Infant wide-field fundus photograph: 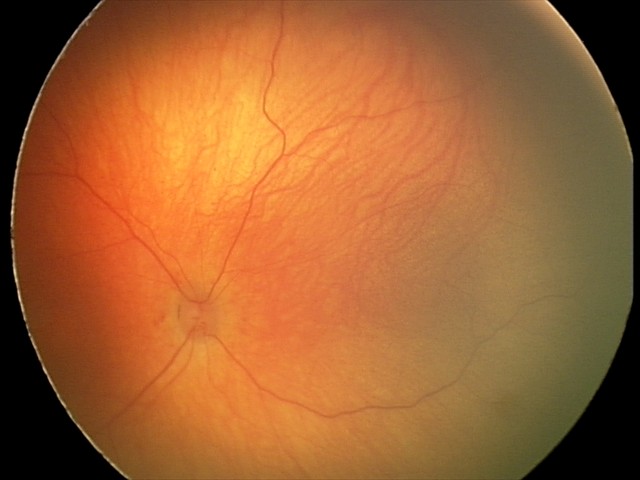
Physiological retinal appearance for postconceptual age.